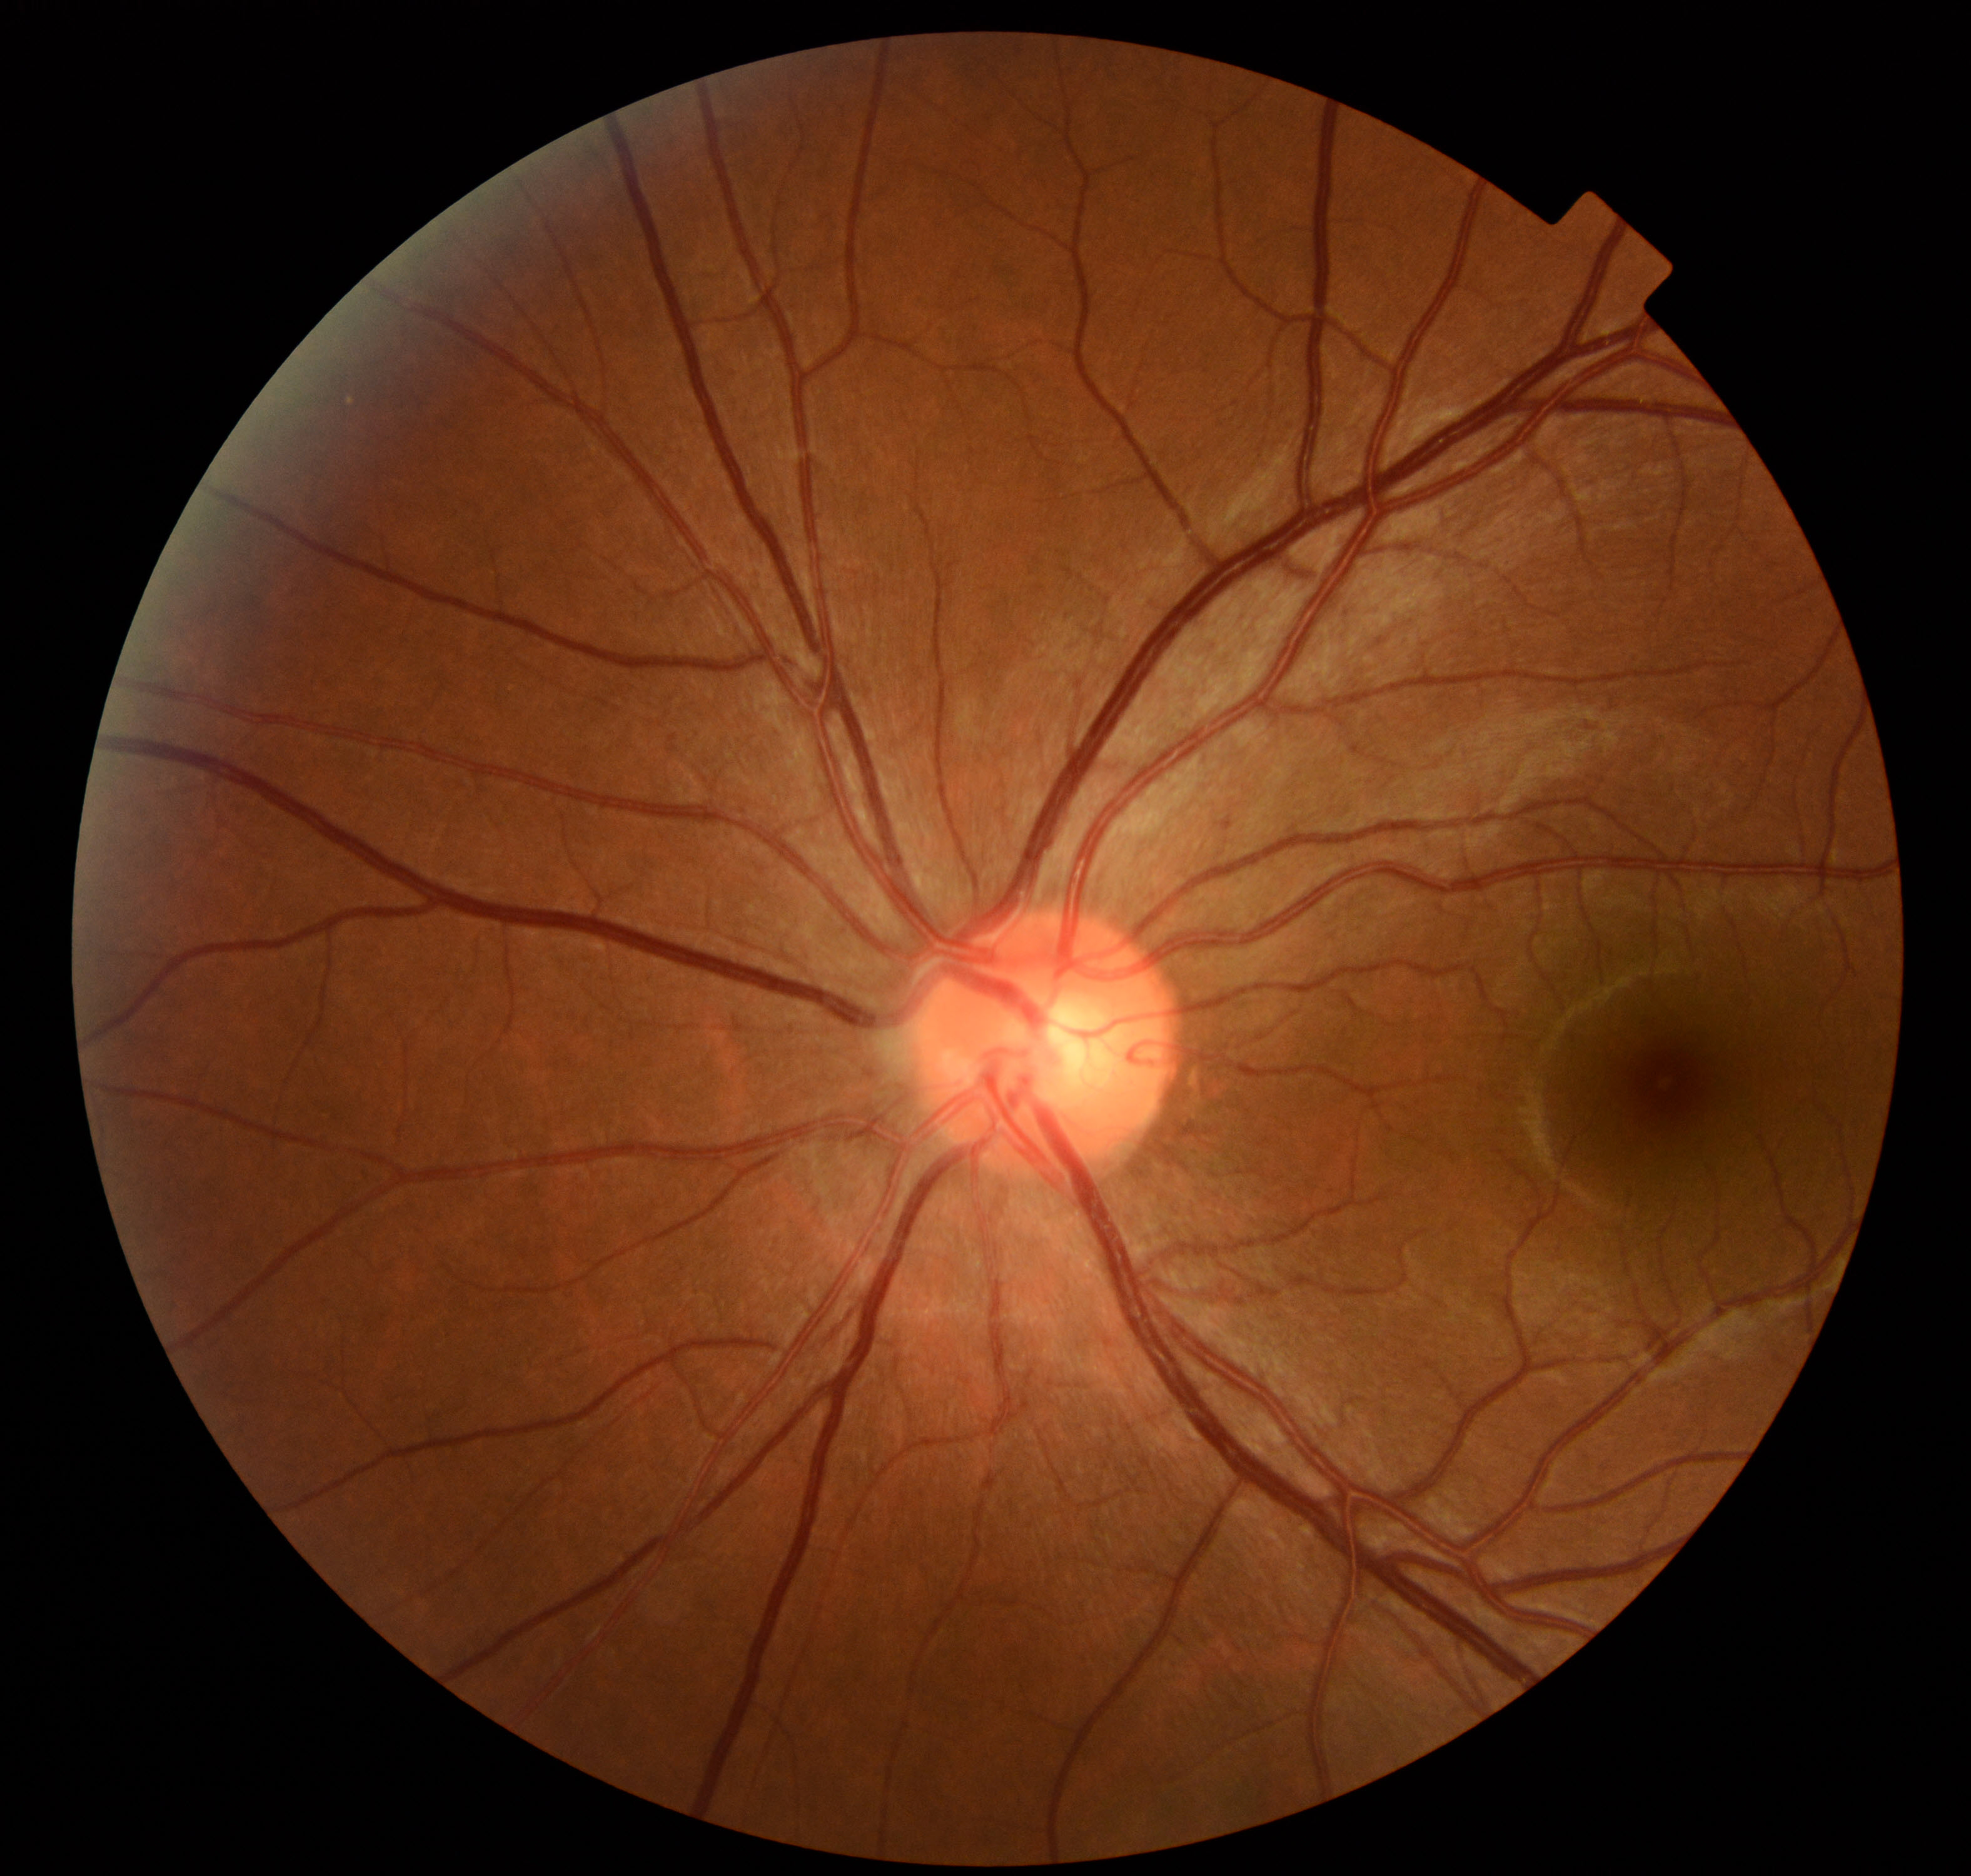

No abnormal findings on fundus examination.